Centered on the optic disc. Color fundus image.
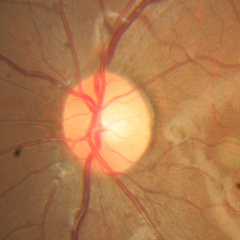

Optic disc appearance consistent with no glaucomatous changes.